Retinal fundus photograph; 2352x1568px.
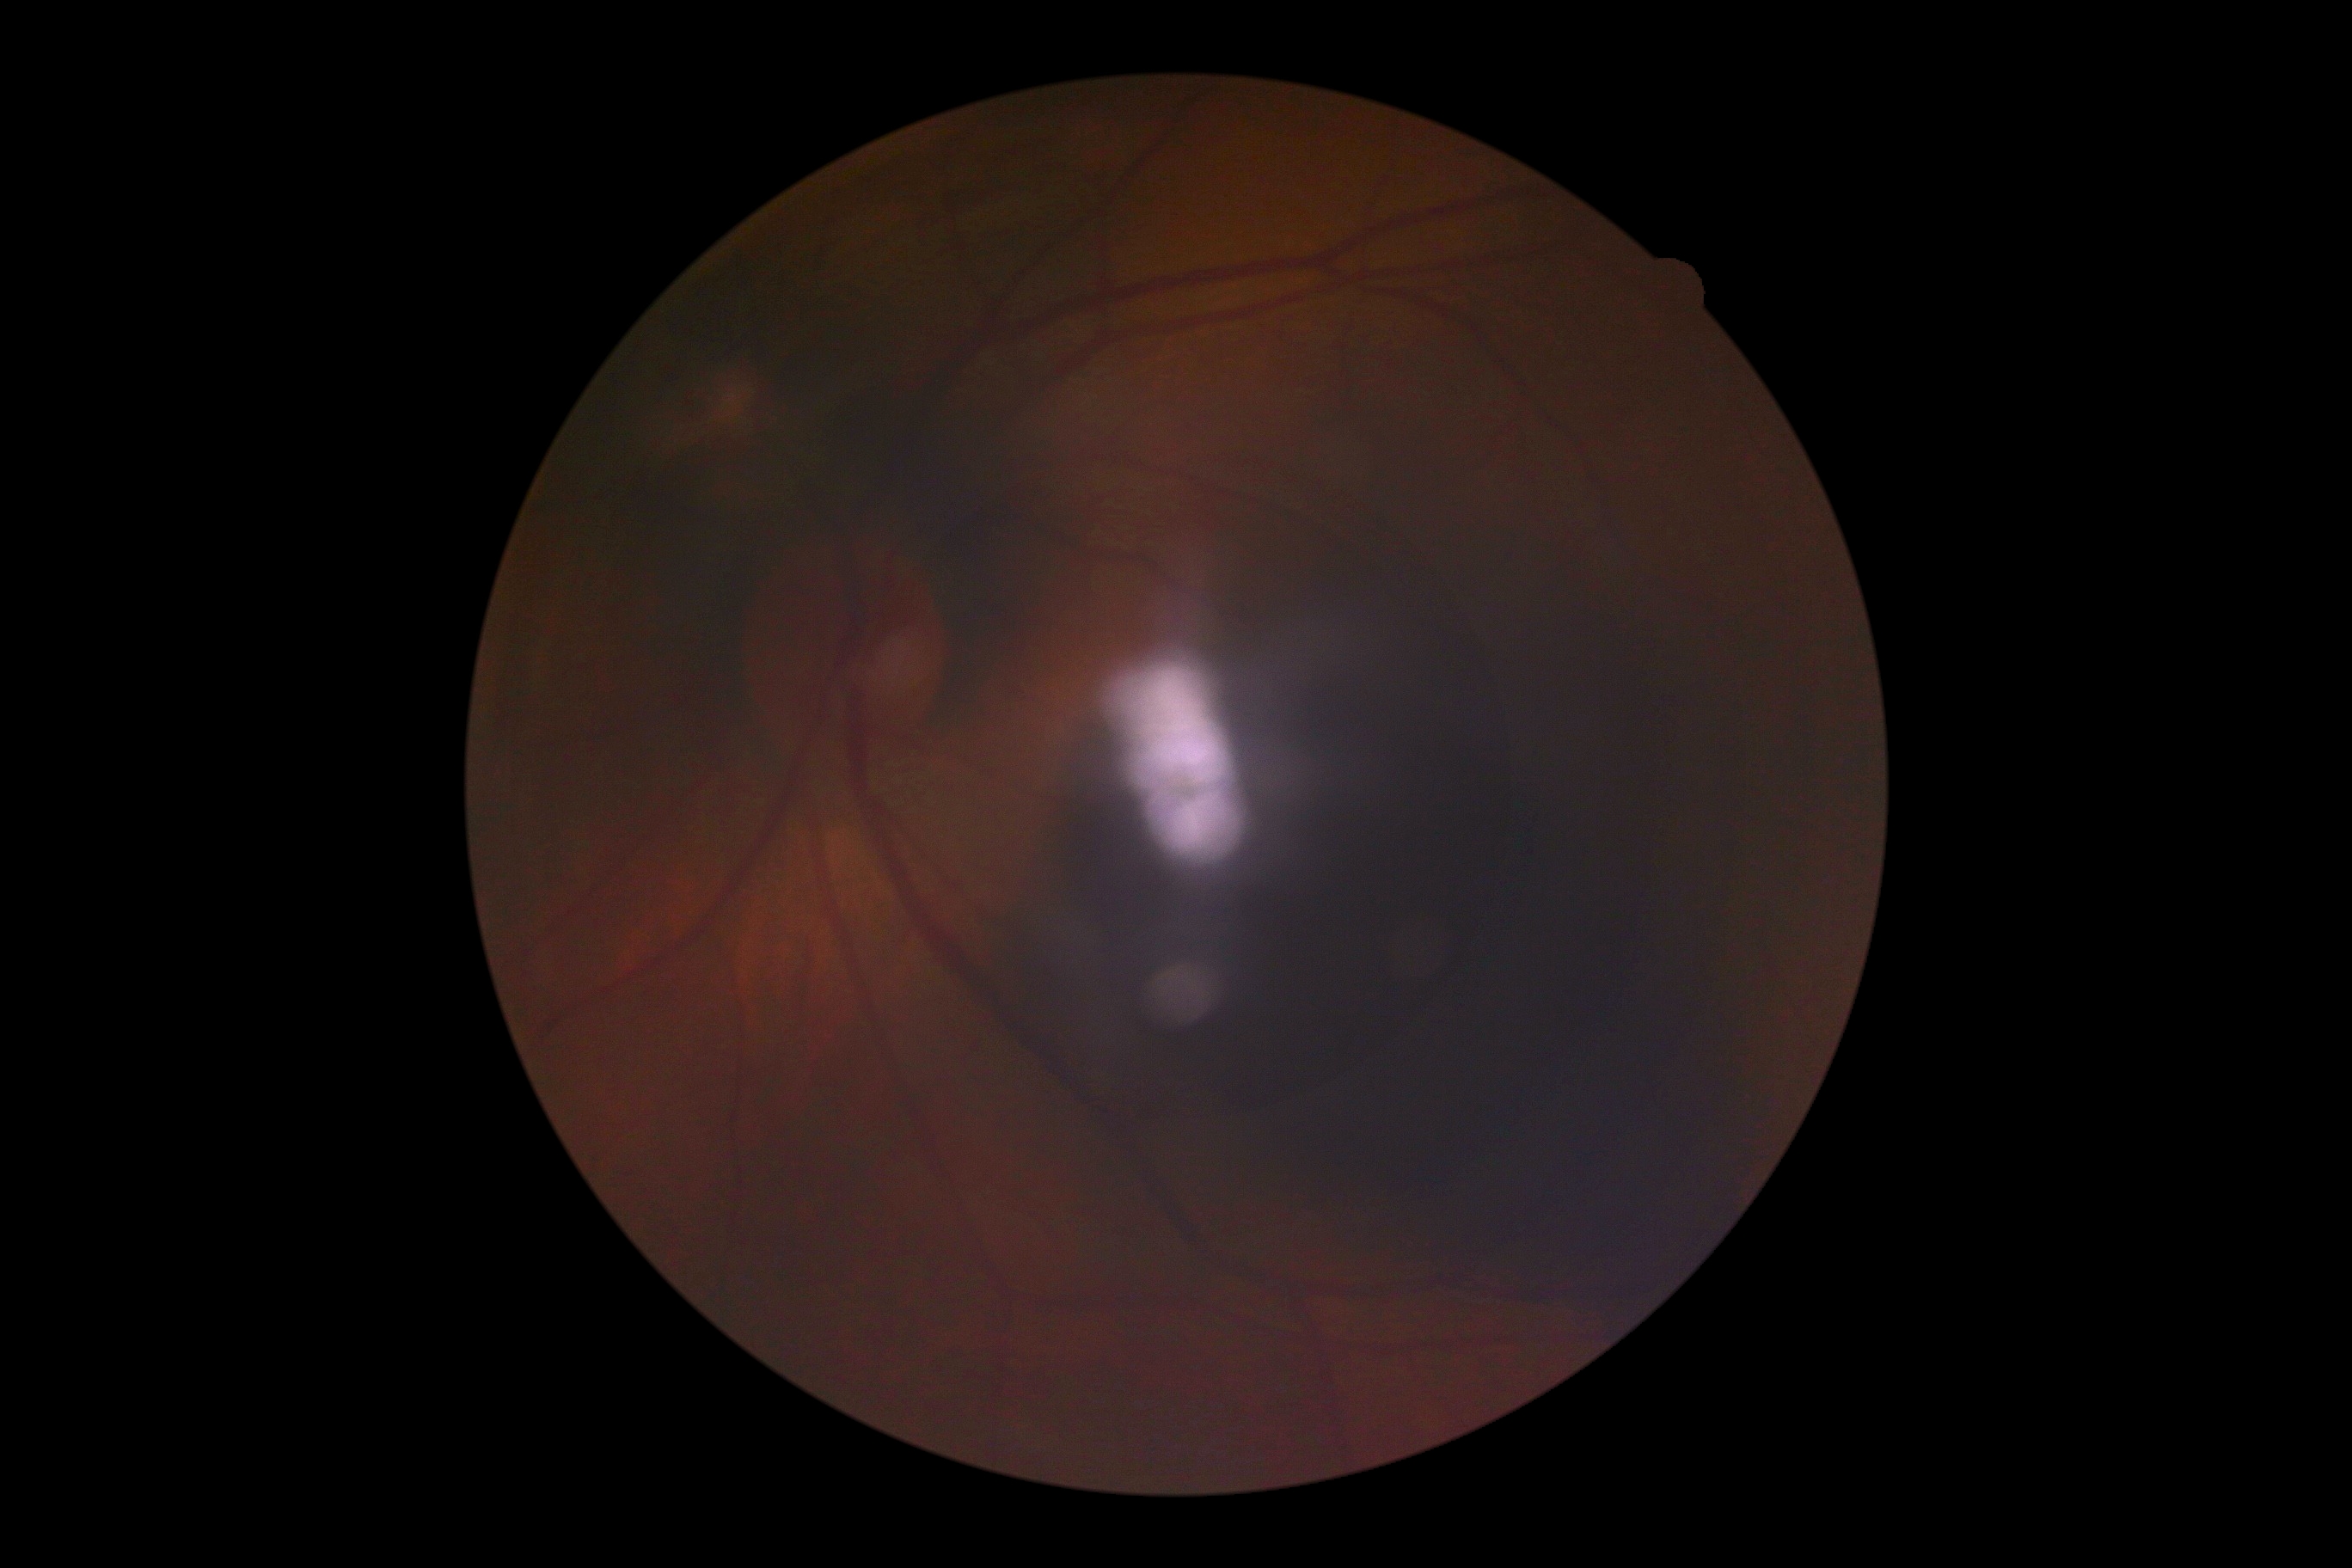 DR stage: ungradable due to poor image quality.